Wide-field fundus photograph from neonatal ROP screening: 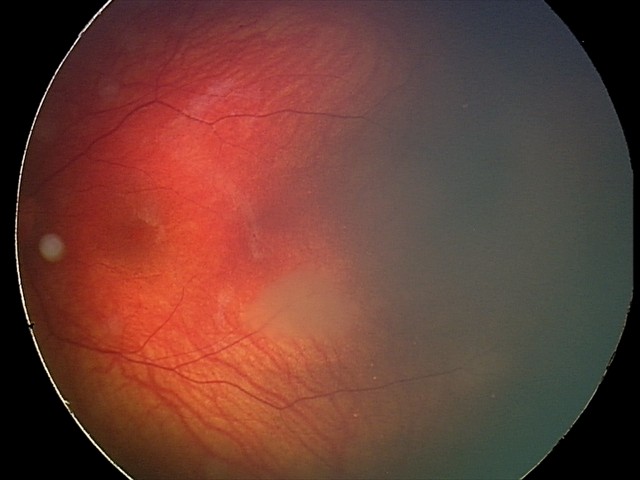

From an examination with diagnosis of retinal astrocytic hamartoma.